45° field of view; modified Davis classification; retinal fundus photograph: 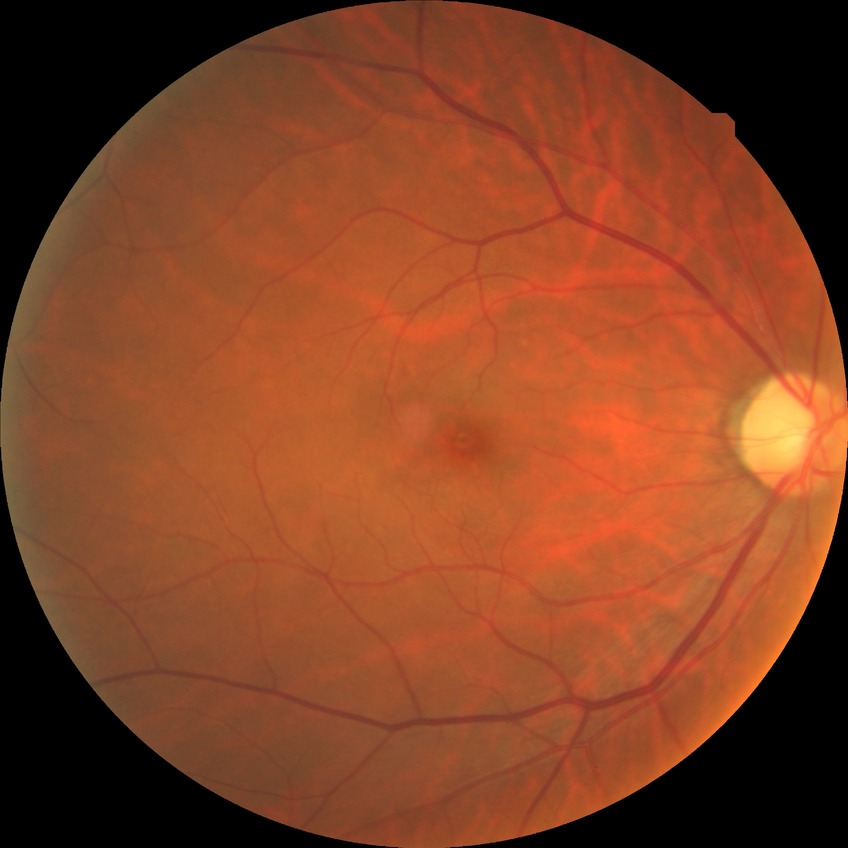
Davis grading = no diabetic retinopathy.